Color fundus image, 45° FOV, 2352 x 1568 pixels: 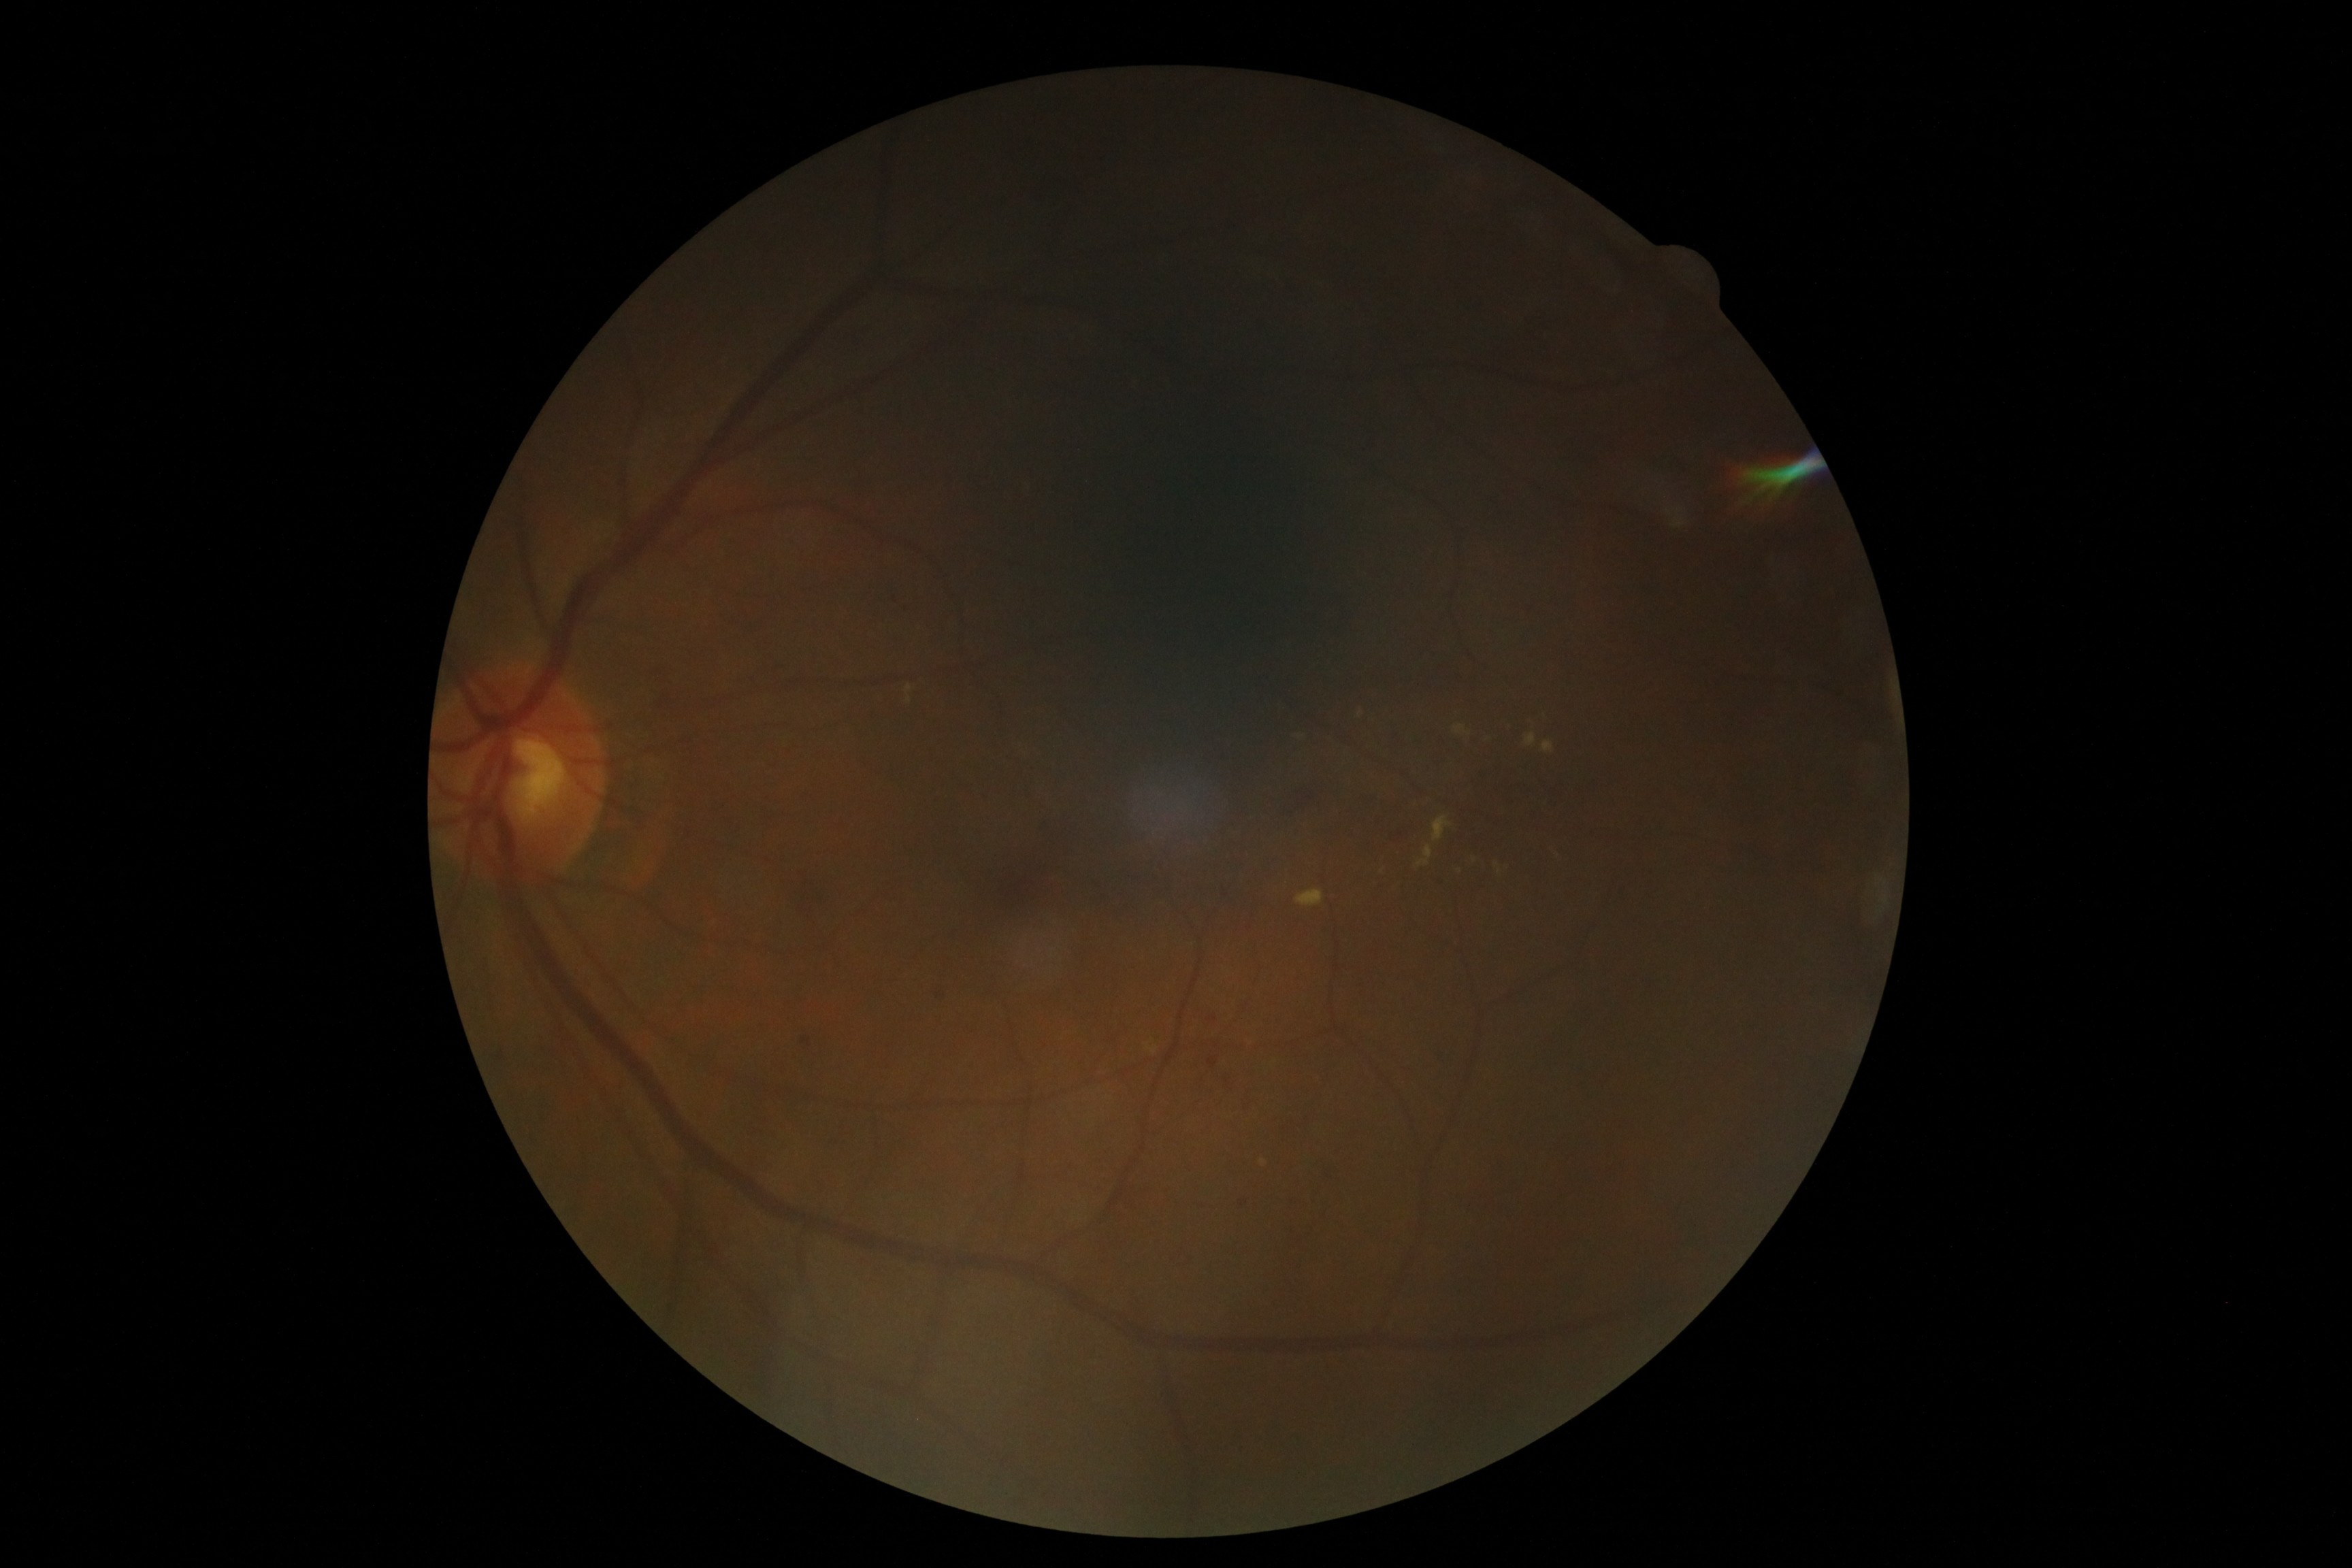

Retinopathy: 2/4.